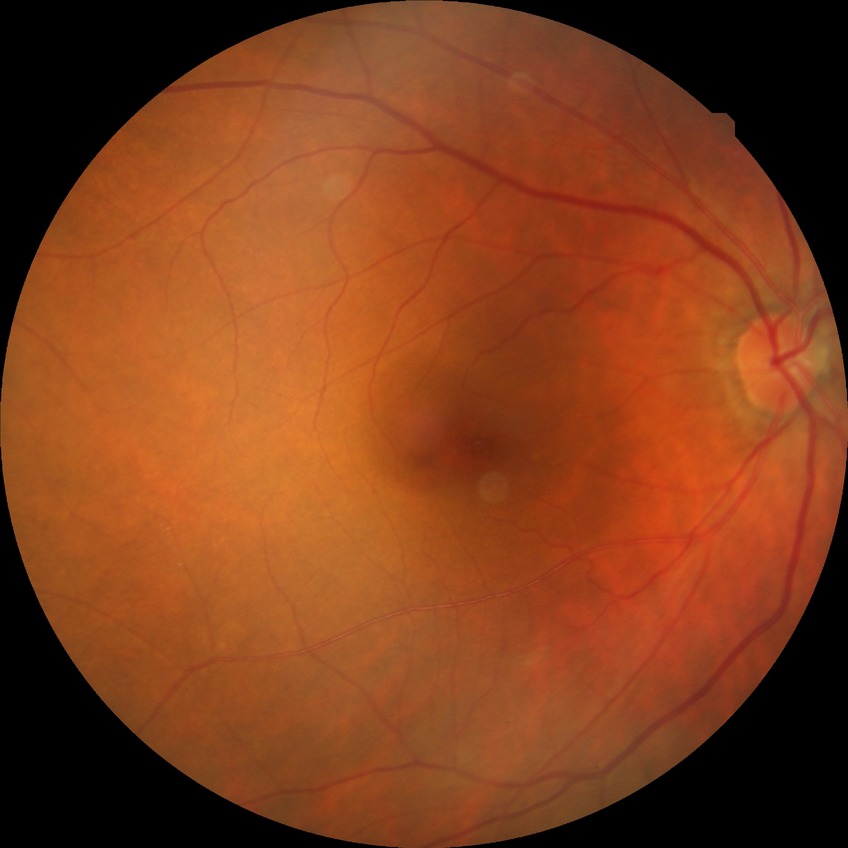

Annotations:
- diabetic retinopathy (DR) — no diabetic retinopathy (NDR)